45° field of view; modified Davis classification; nonmydriatic fundus photograph; acquired with a NIDEK AFC-230; fundus photo; 848x848: 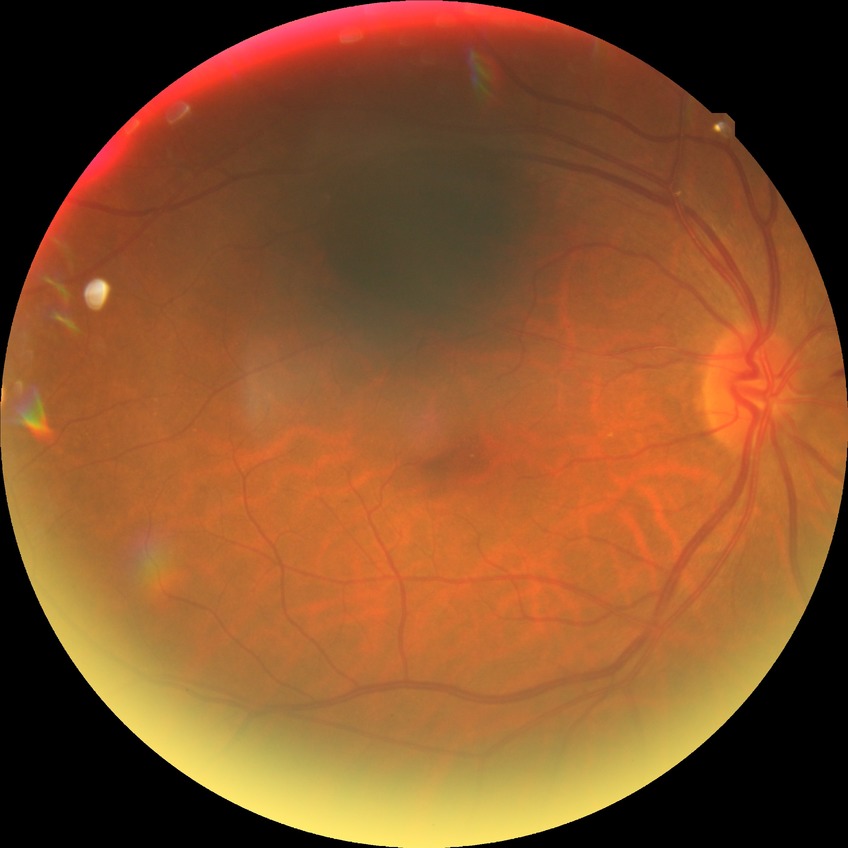

Modified Davis classification: no diabetic retinopathy.